2212x1659
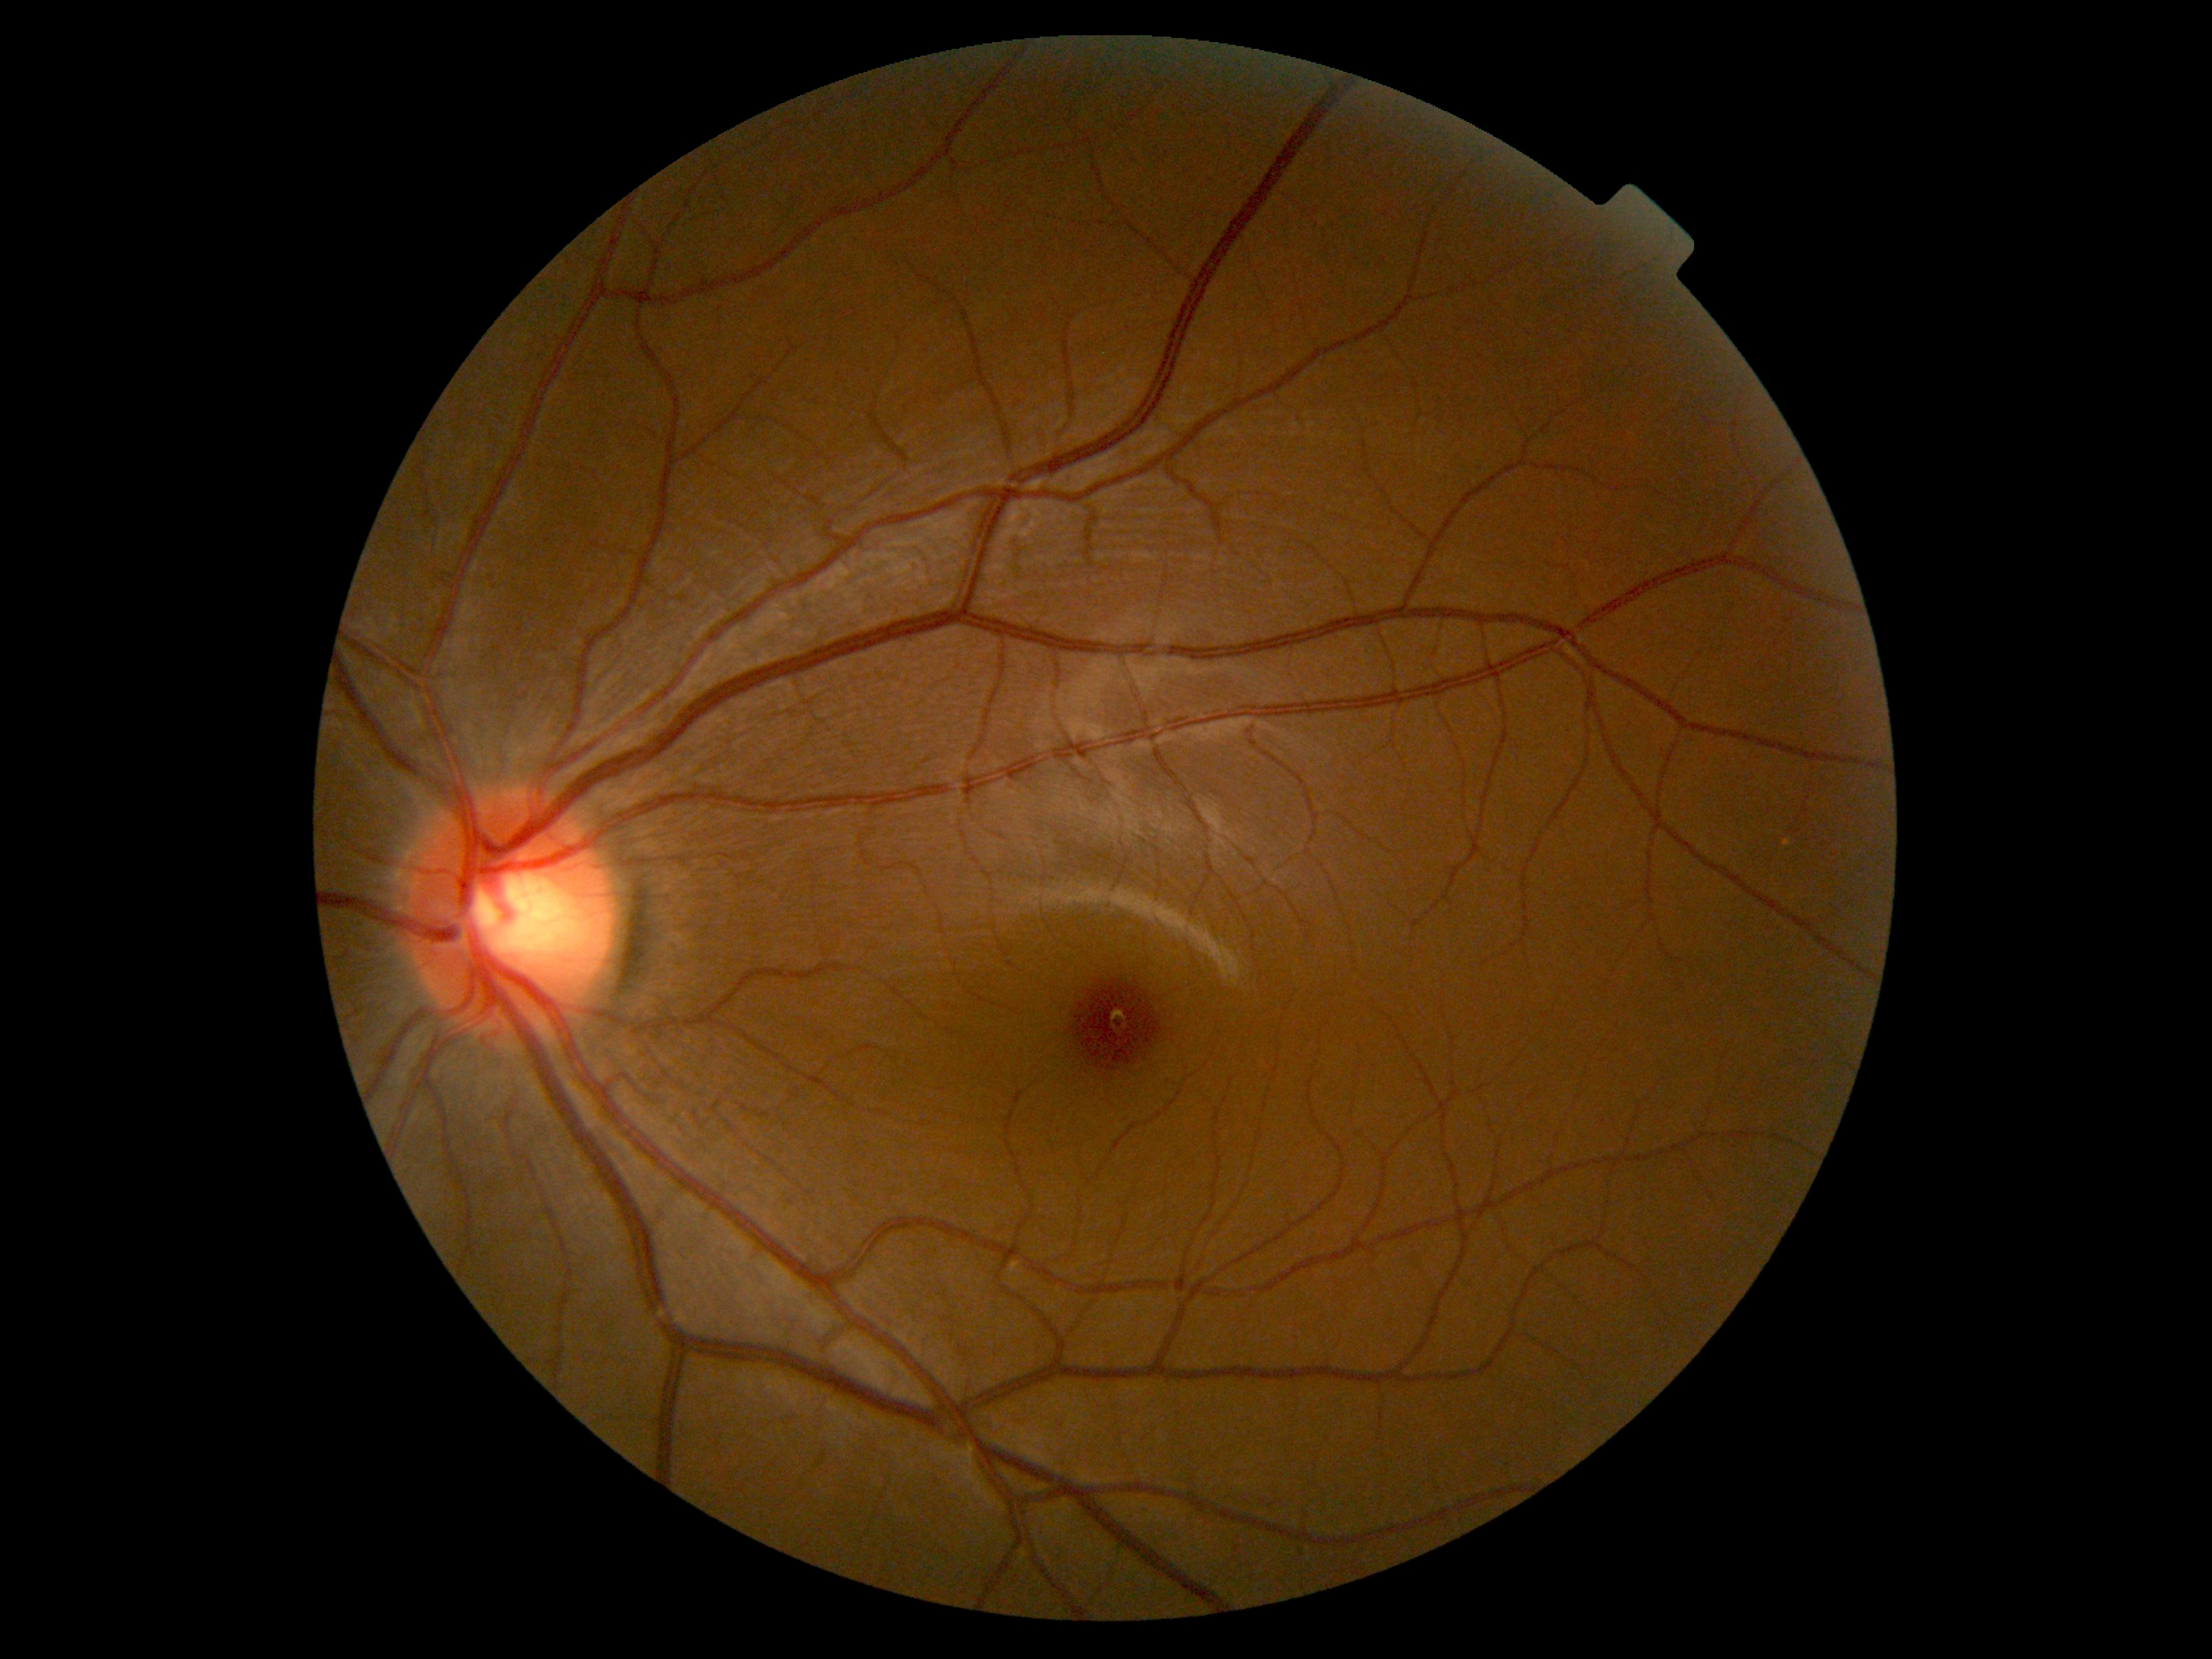

DR impression=no DR findings; diabetic retinopathy grade=0.